640 by 480 pixels; pediatric retinal photograph (wide-field).
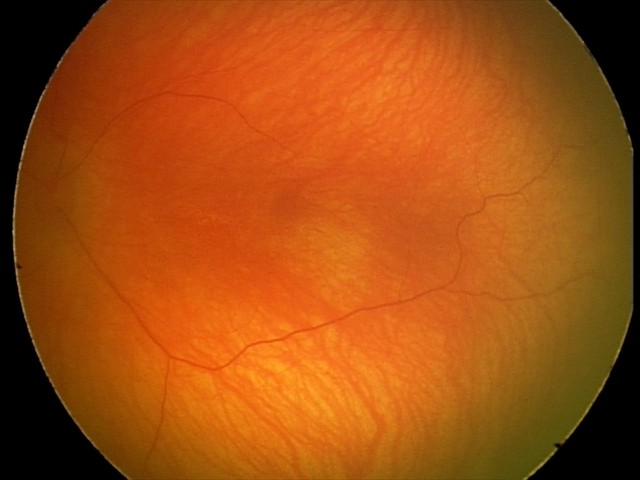
Impression: normal fundus examination.